2212x1659 — 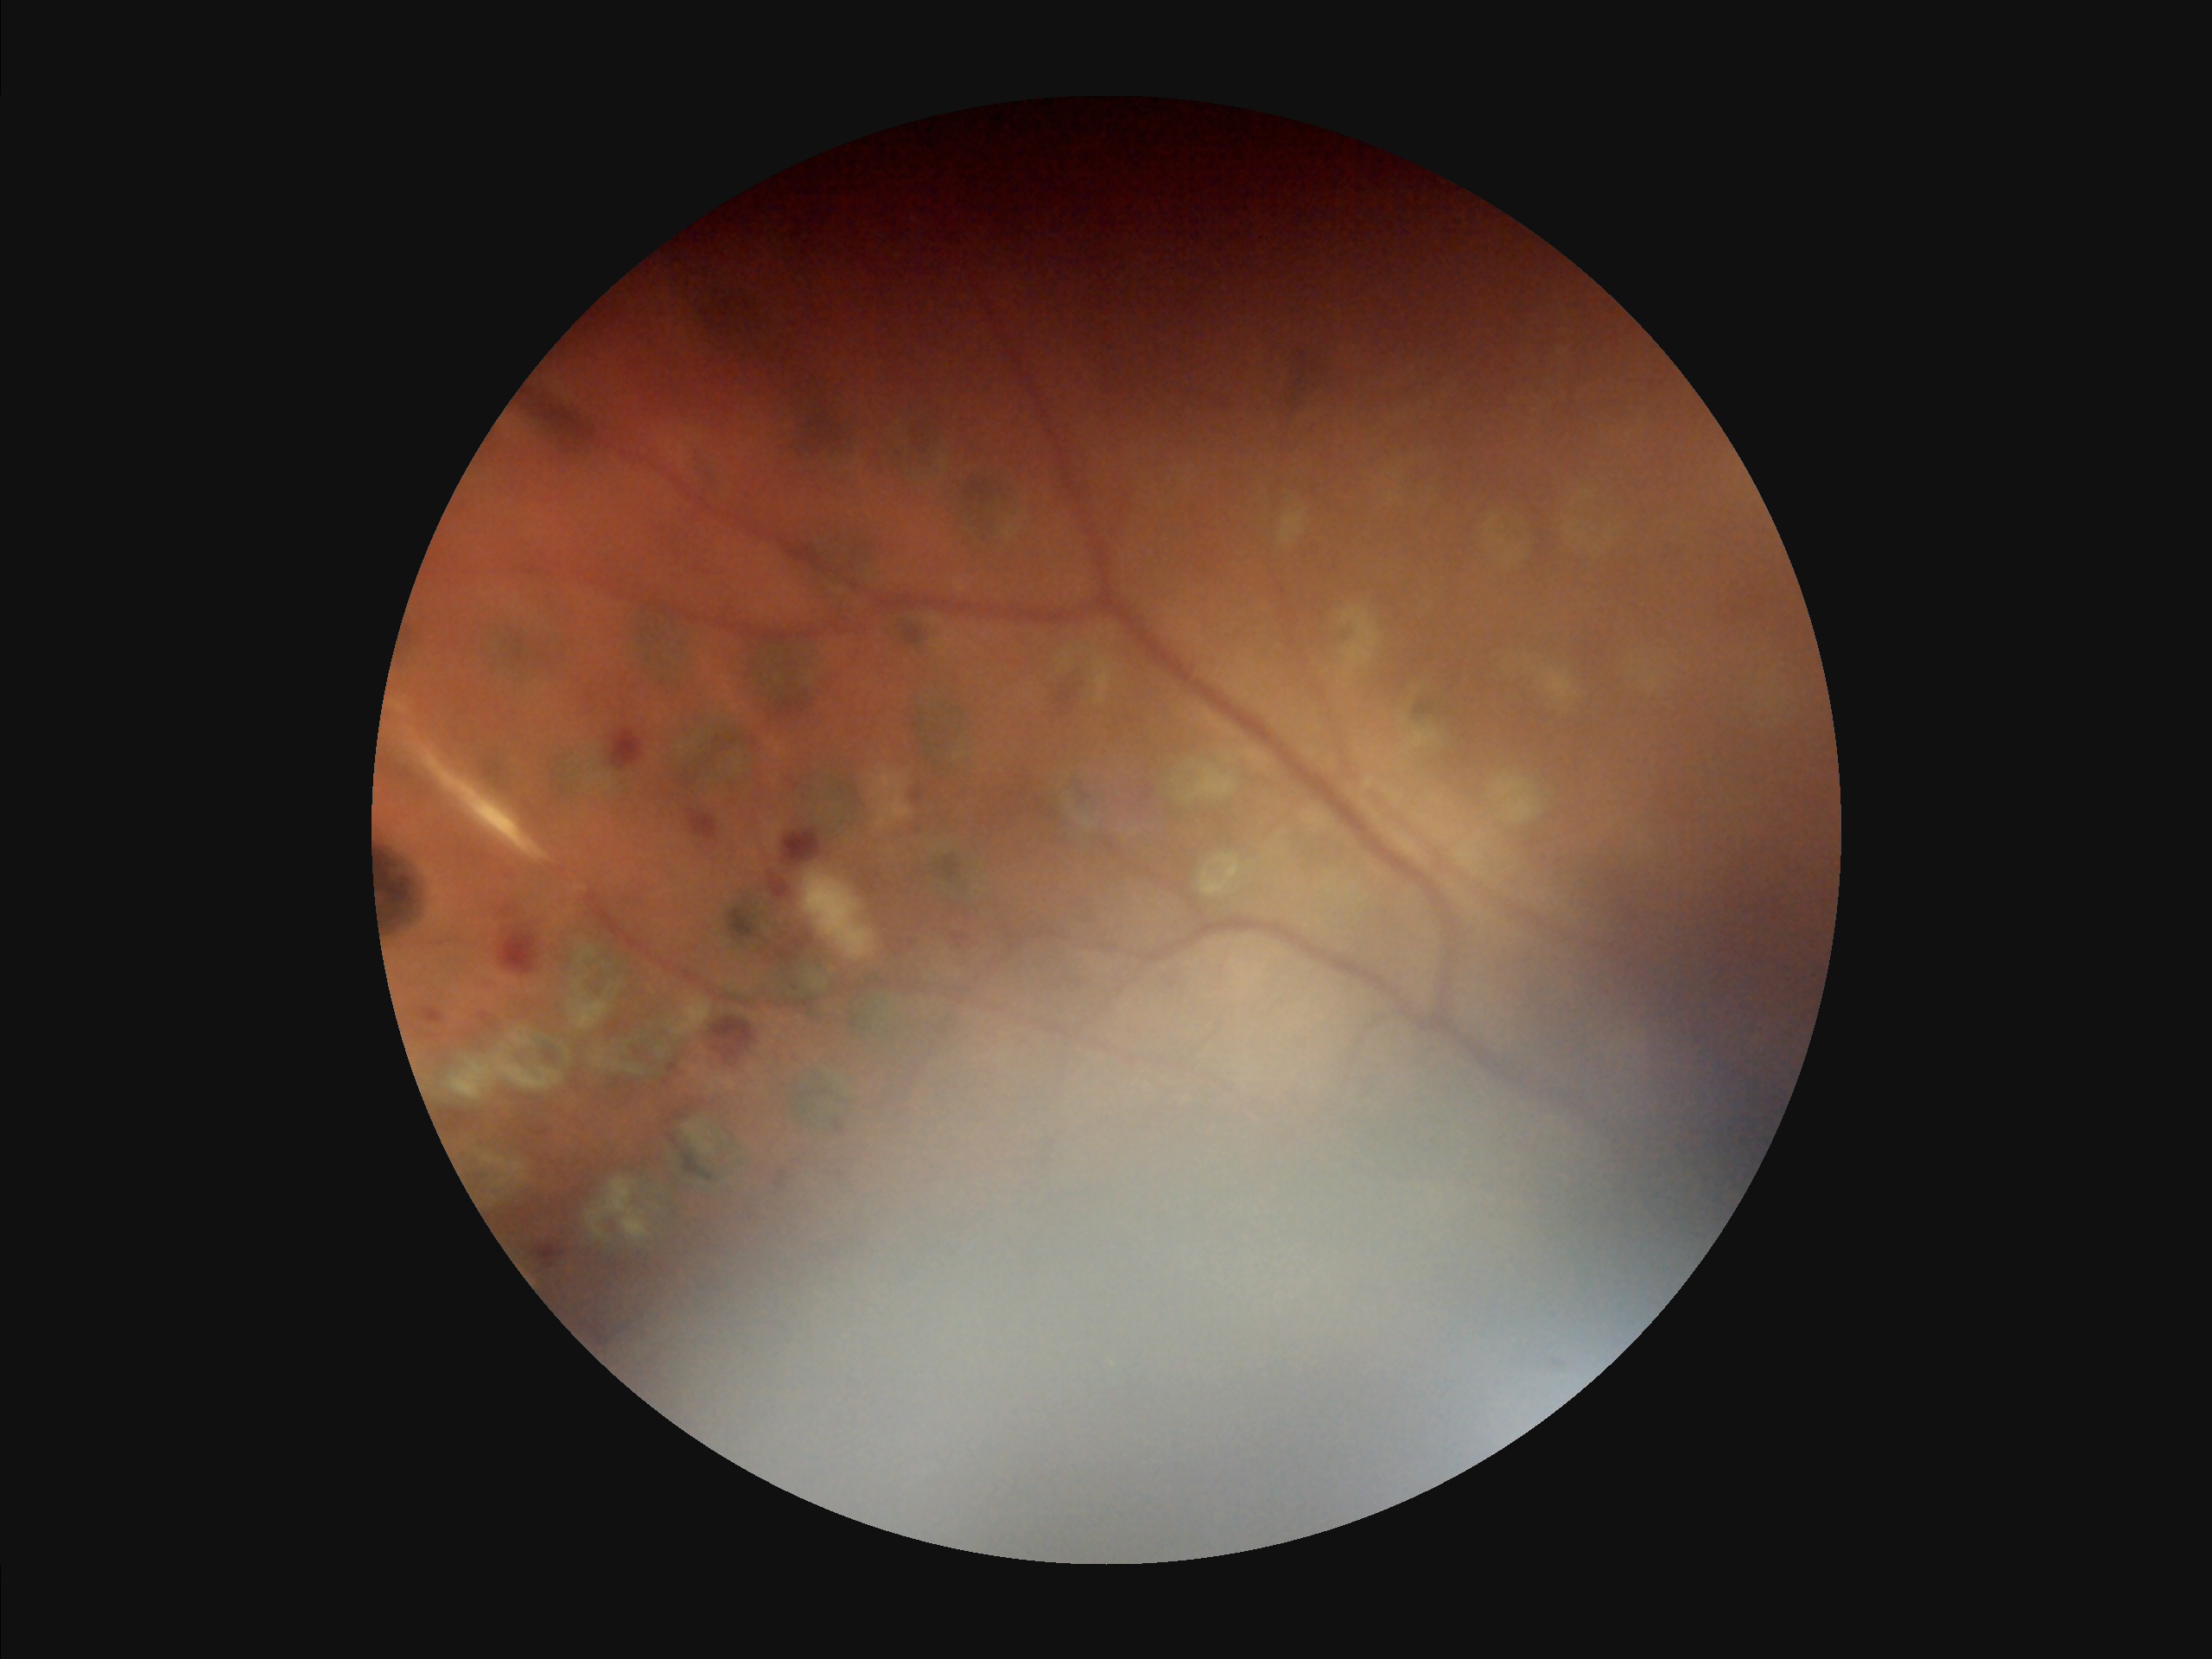

Noticeable blur in the optic disc, vessels, or background. Narrow intensity range; structures are hard to distinguish. There is over- or under-exposure or a color cast. Overall image quality is poor.